Wide-field fundus photograph from neonatal ROP screening; 100° field of view (Phoenix ICON): 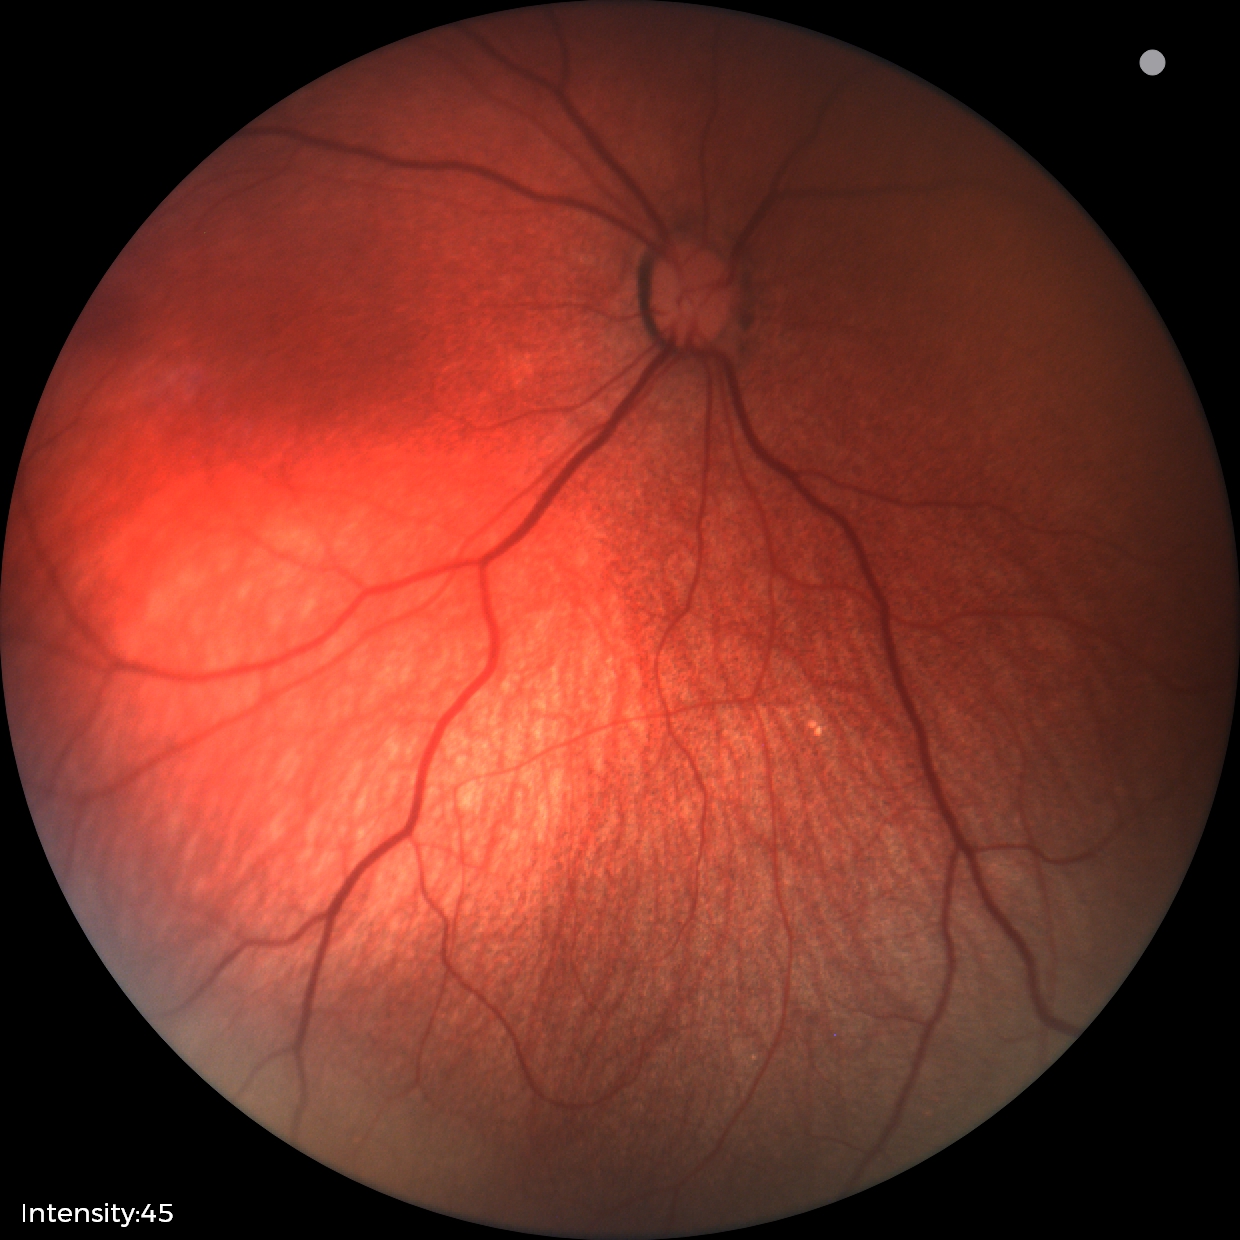
Assessment: no abnormal retinal findings.